45° FOV.
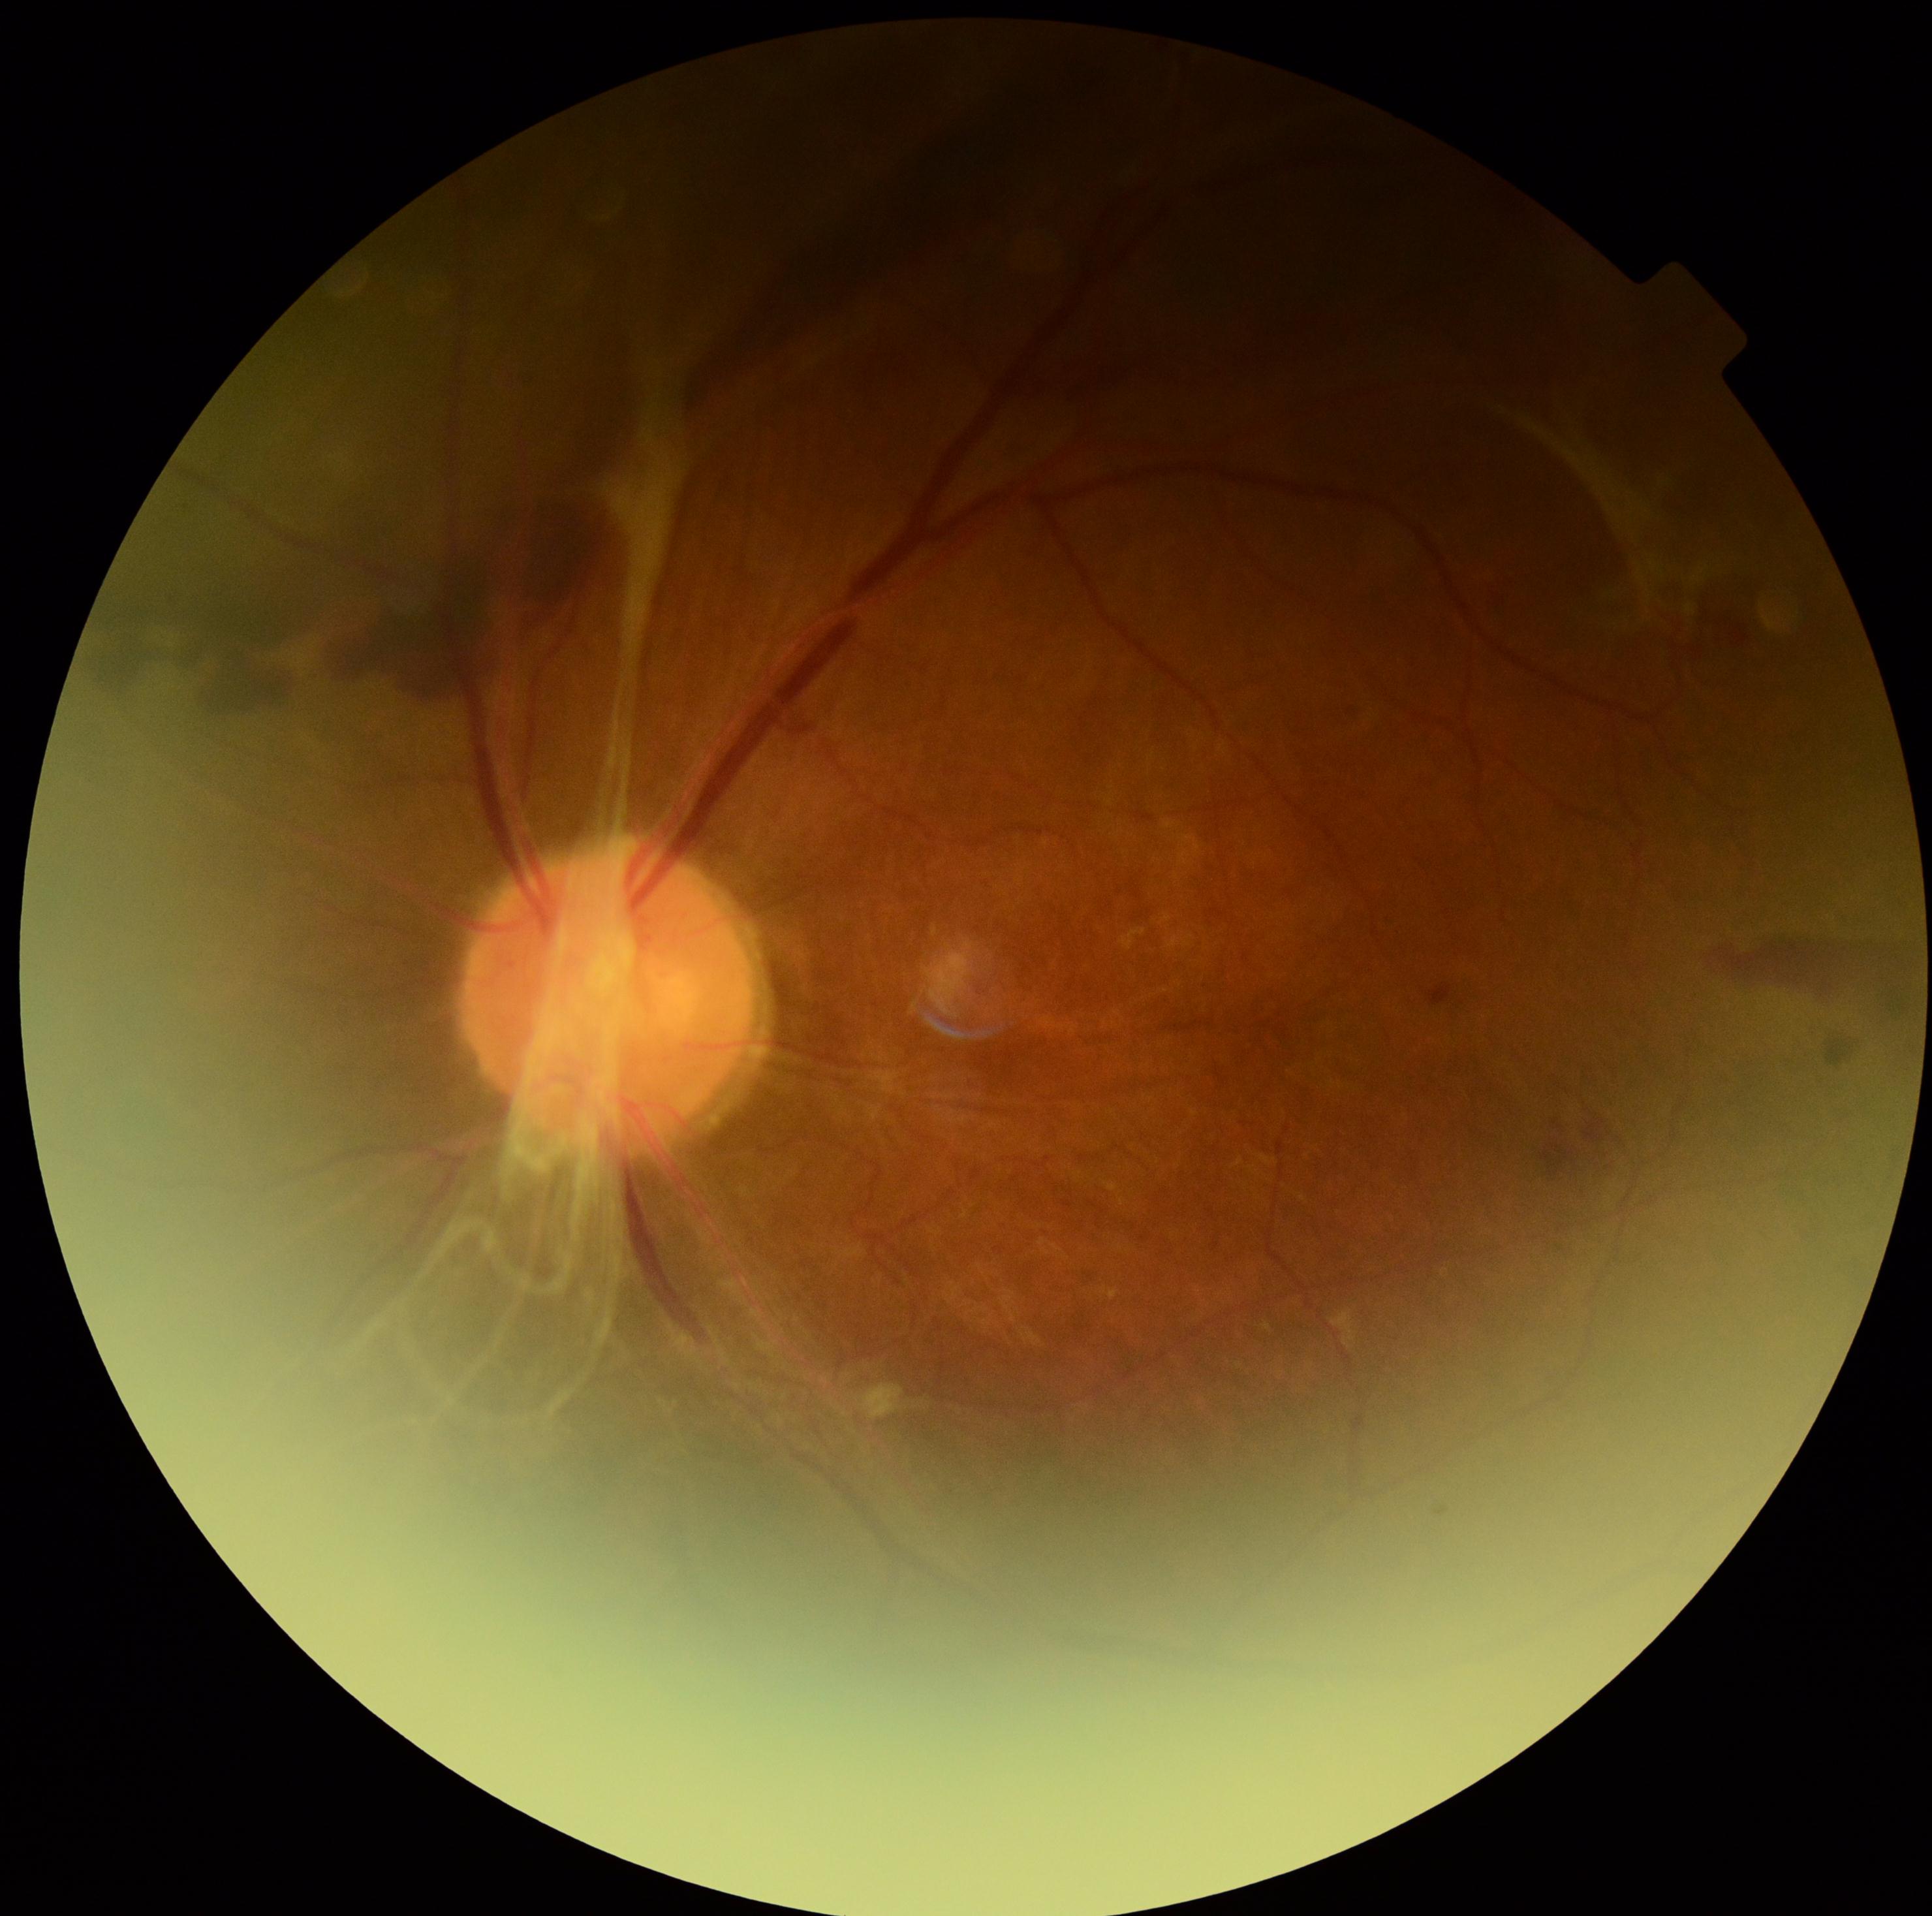

DR class: proliferative diabetic retinopathy | DR: grade 4 (PDR).